UWF retinal mosaic. FOV: 200 degrees — 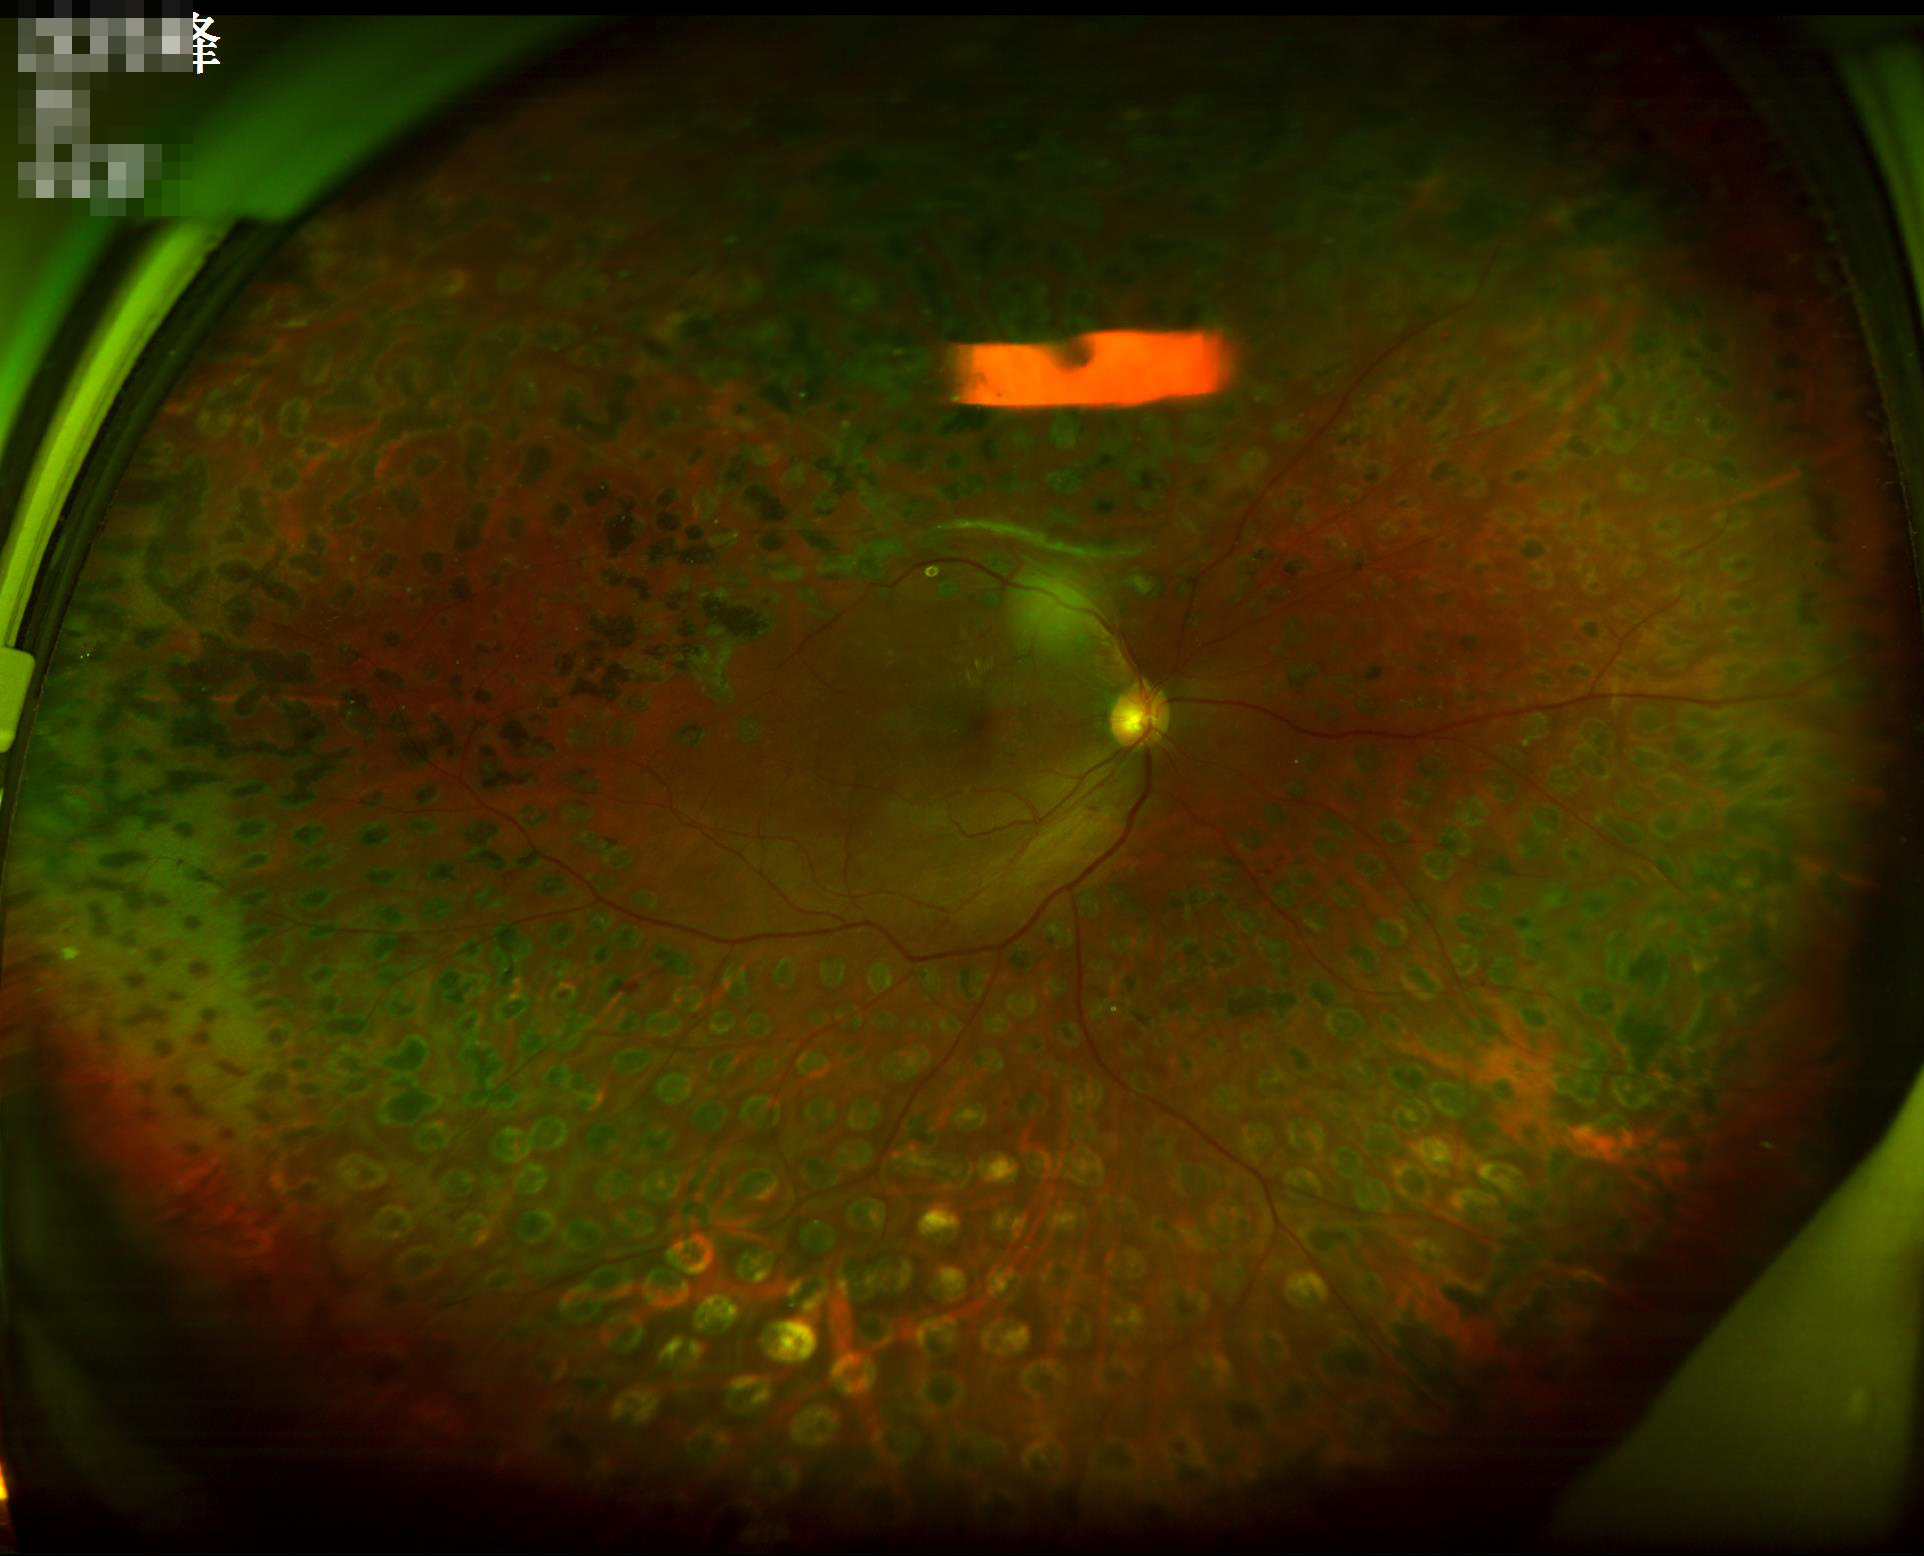

{
  "overall_quality": "adequate",
  "illumination": "uneven",
  "clarity": "good",
  "contrast": "good"
}